45-degree field of view; color fundus photograph.
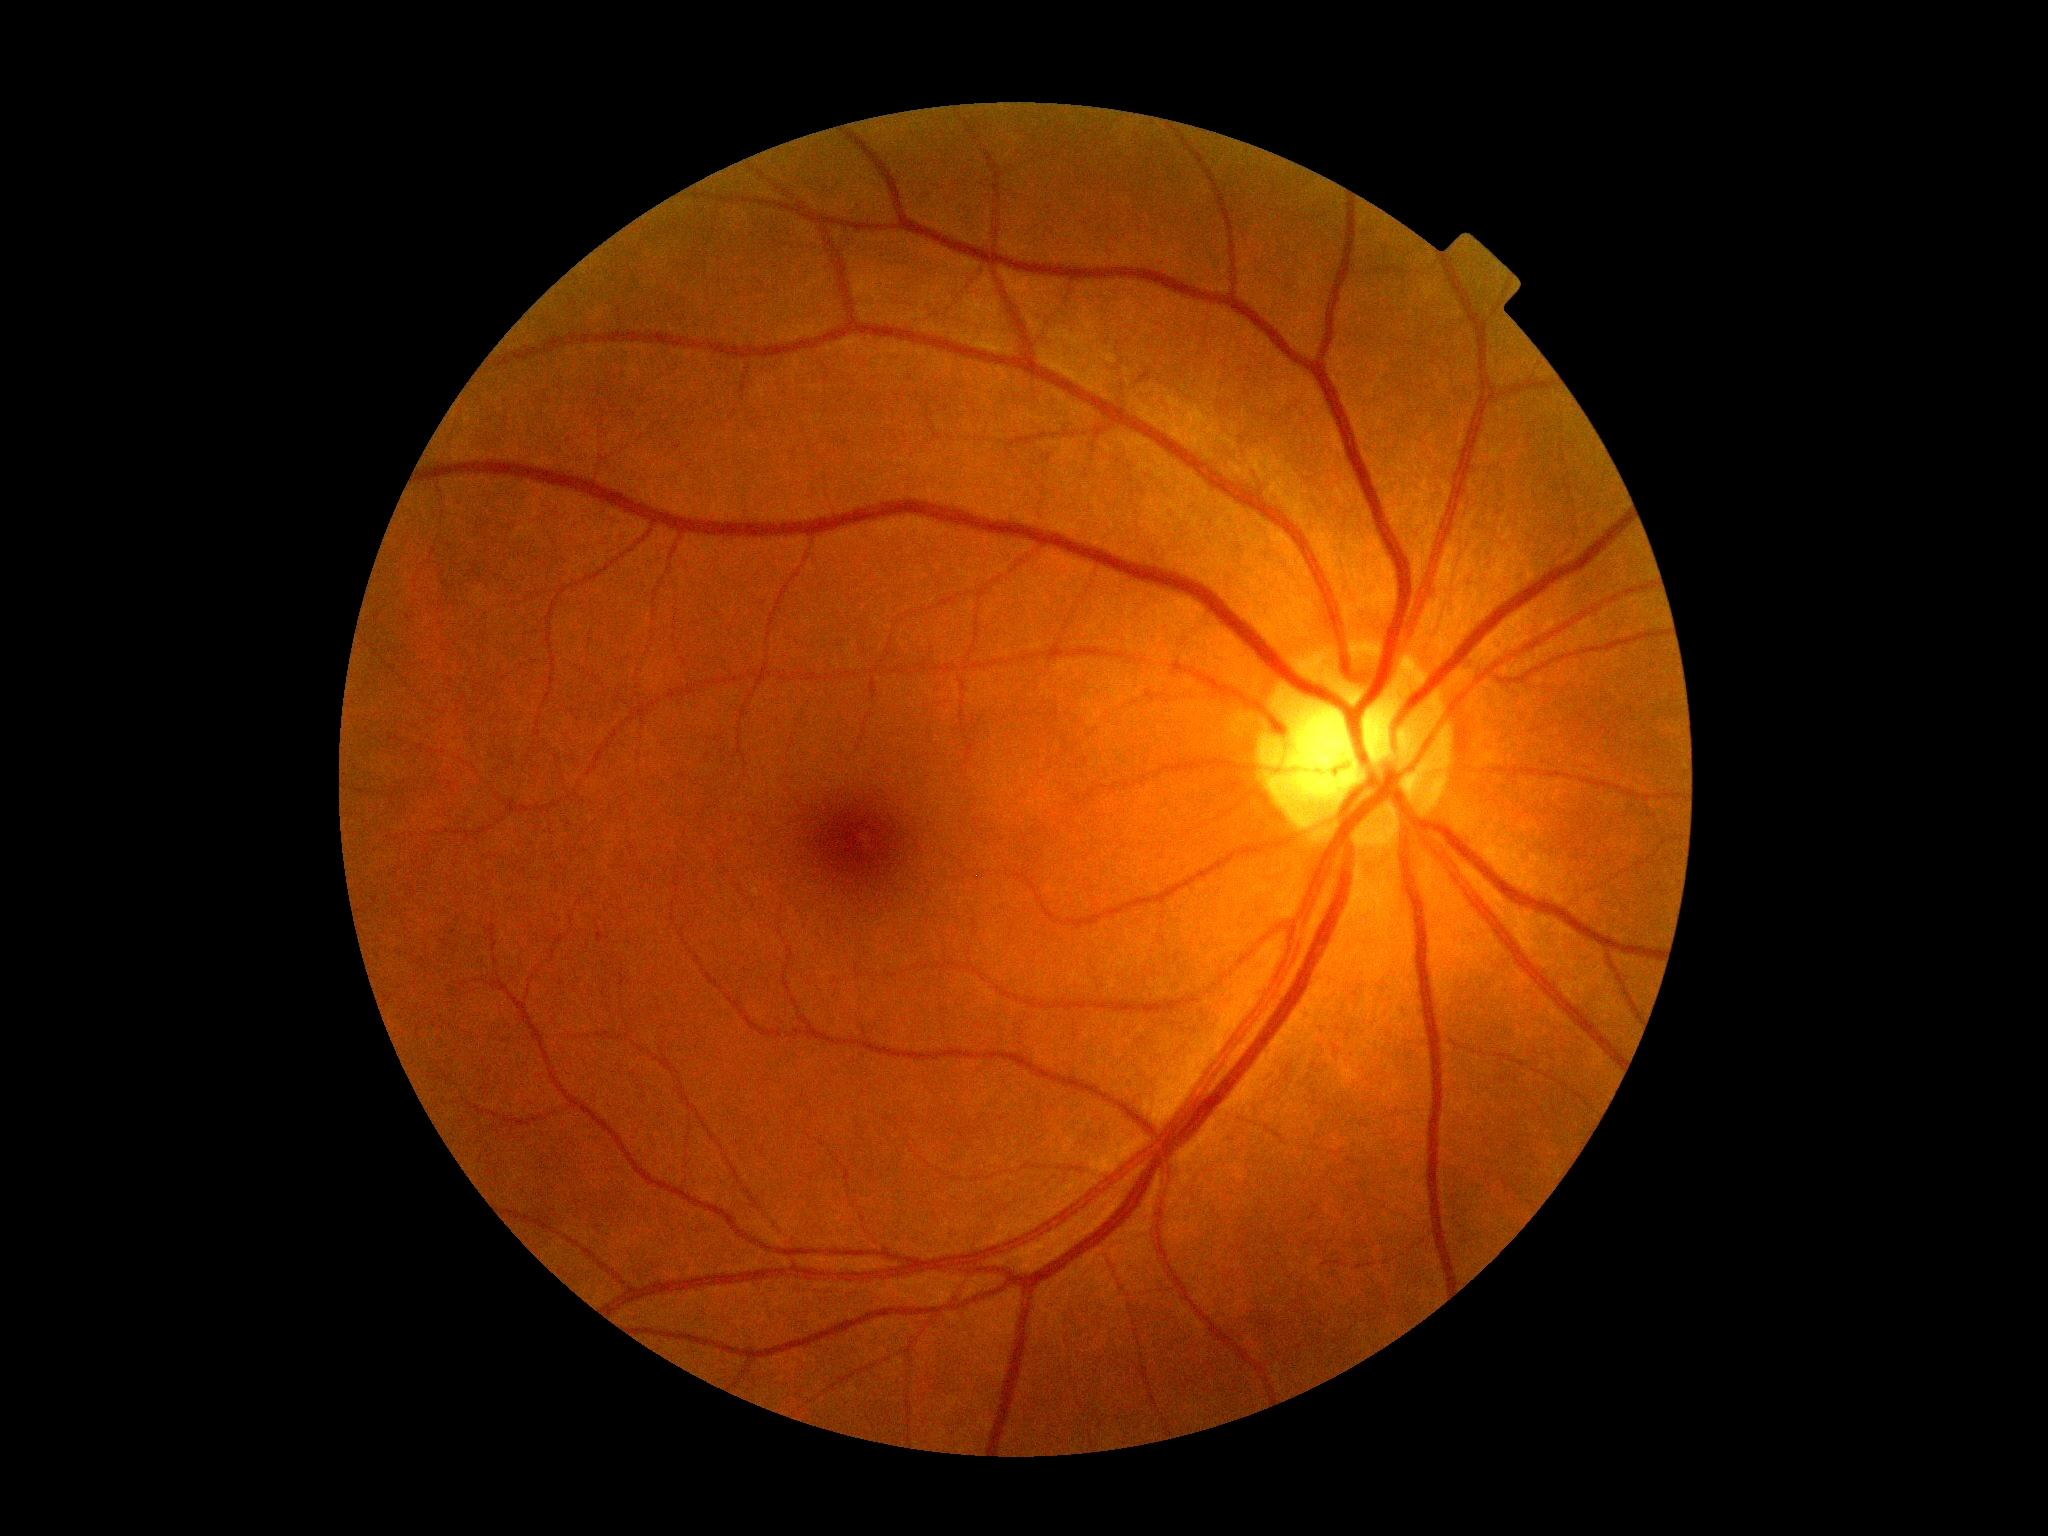
Diabetic retinopathy (DR): 0/4.